848 by 848 pixels · NIDEK AFC-230 · 45-degree field of view
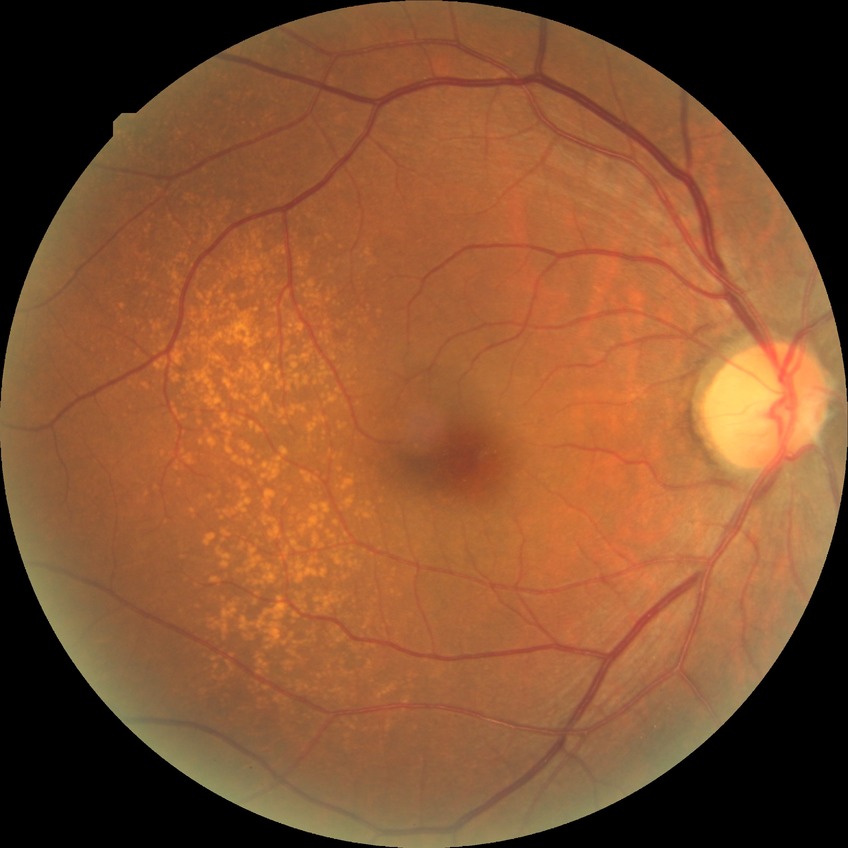

No DR findings. DR severity is NDR.